Davis DR grading: 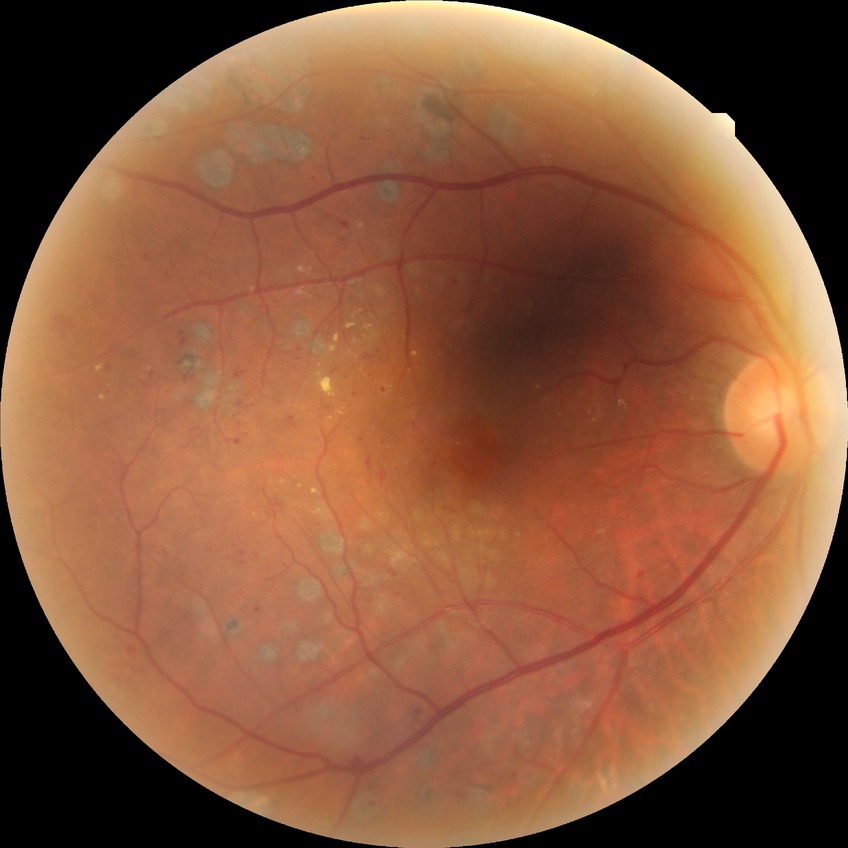

Diabetic retinopathy (DR) is PDR (proliferative diabetic retinopathy).